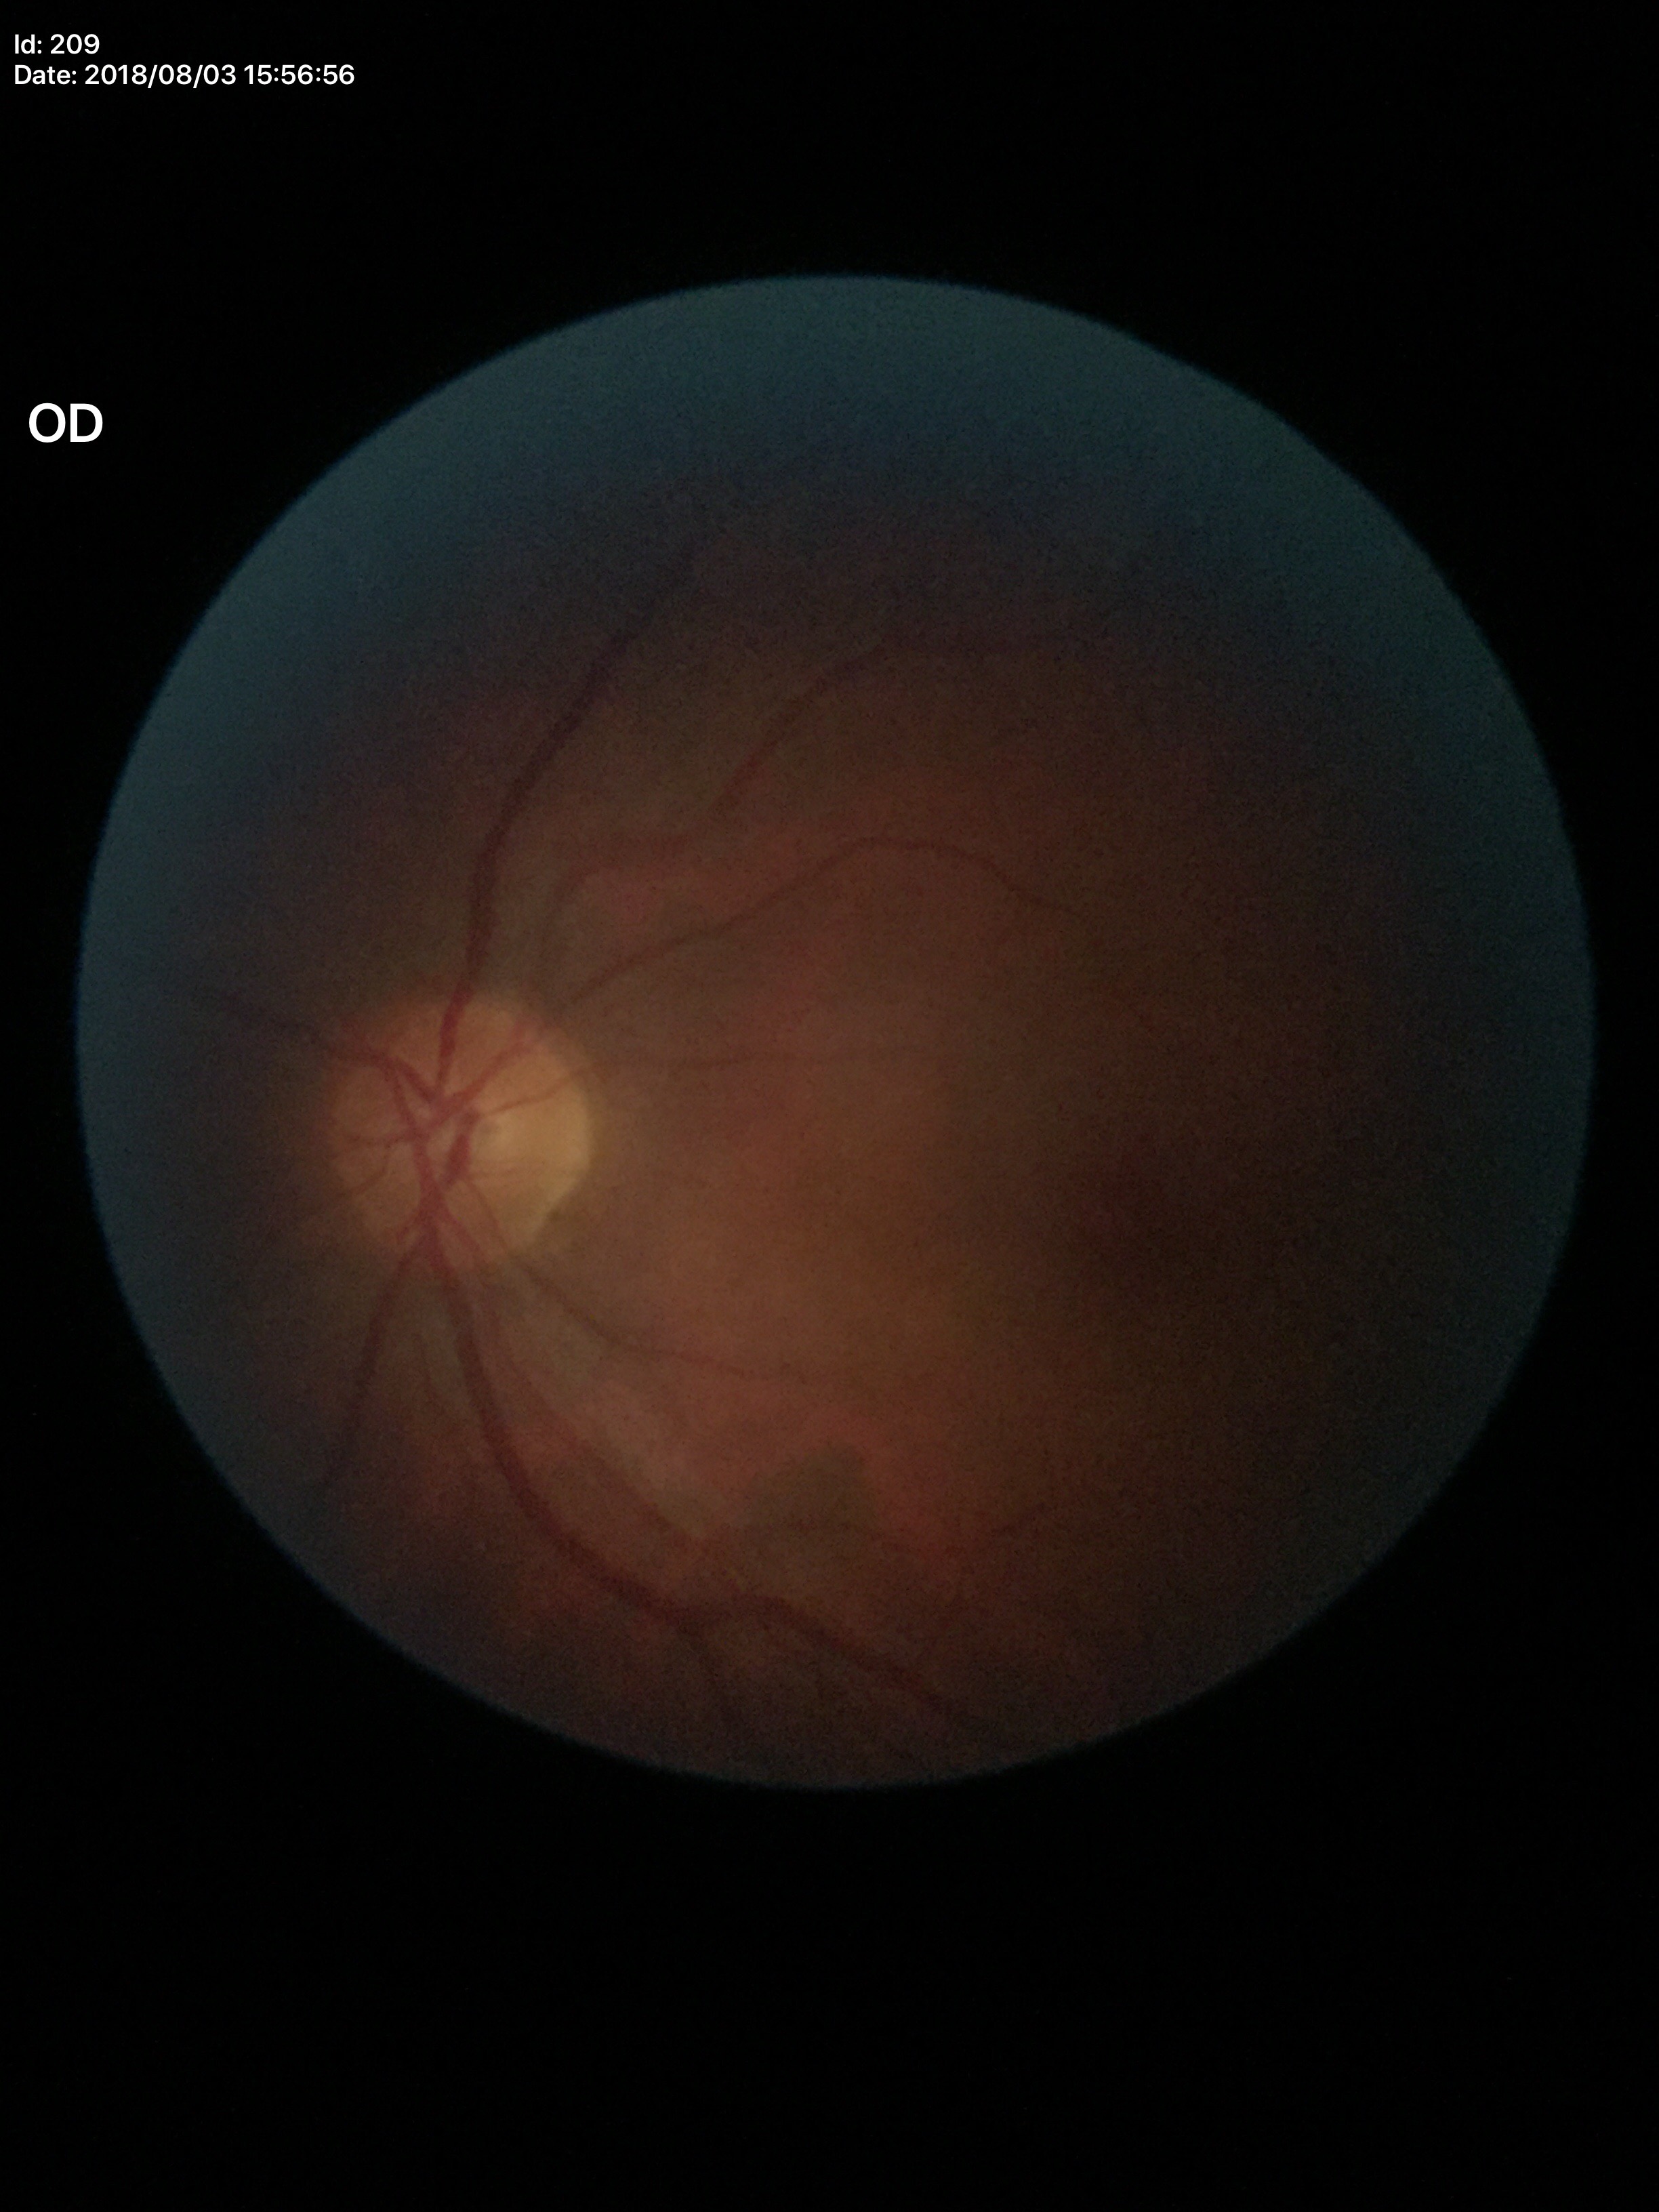
Glaucoma screening impression: no suspicious findings.
Vertical cup-to-disc ratio (VCDR): 0.48.